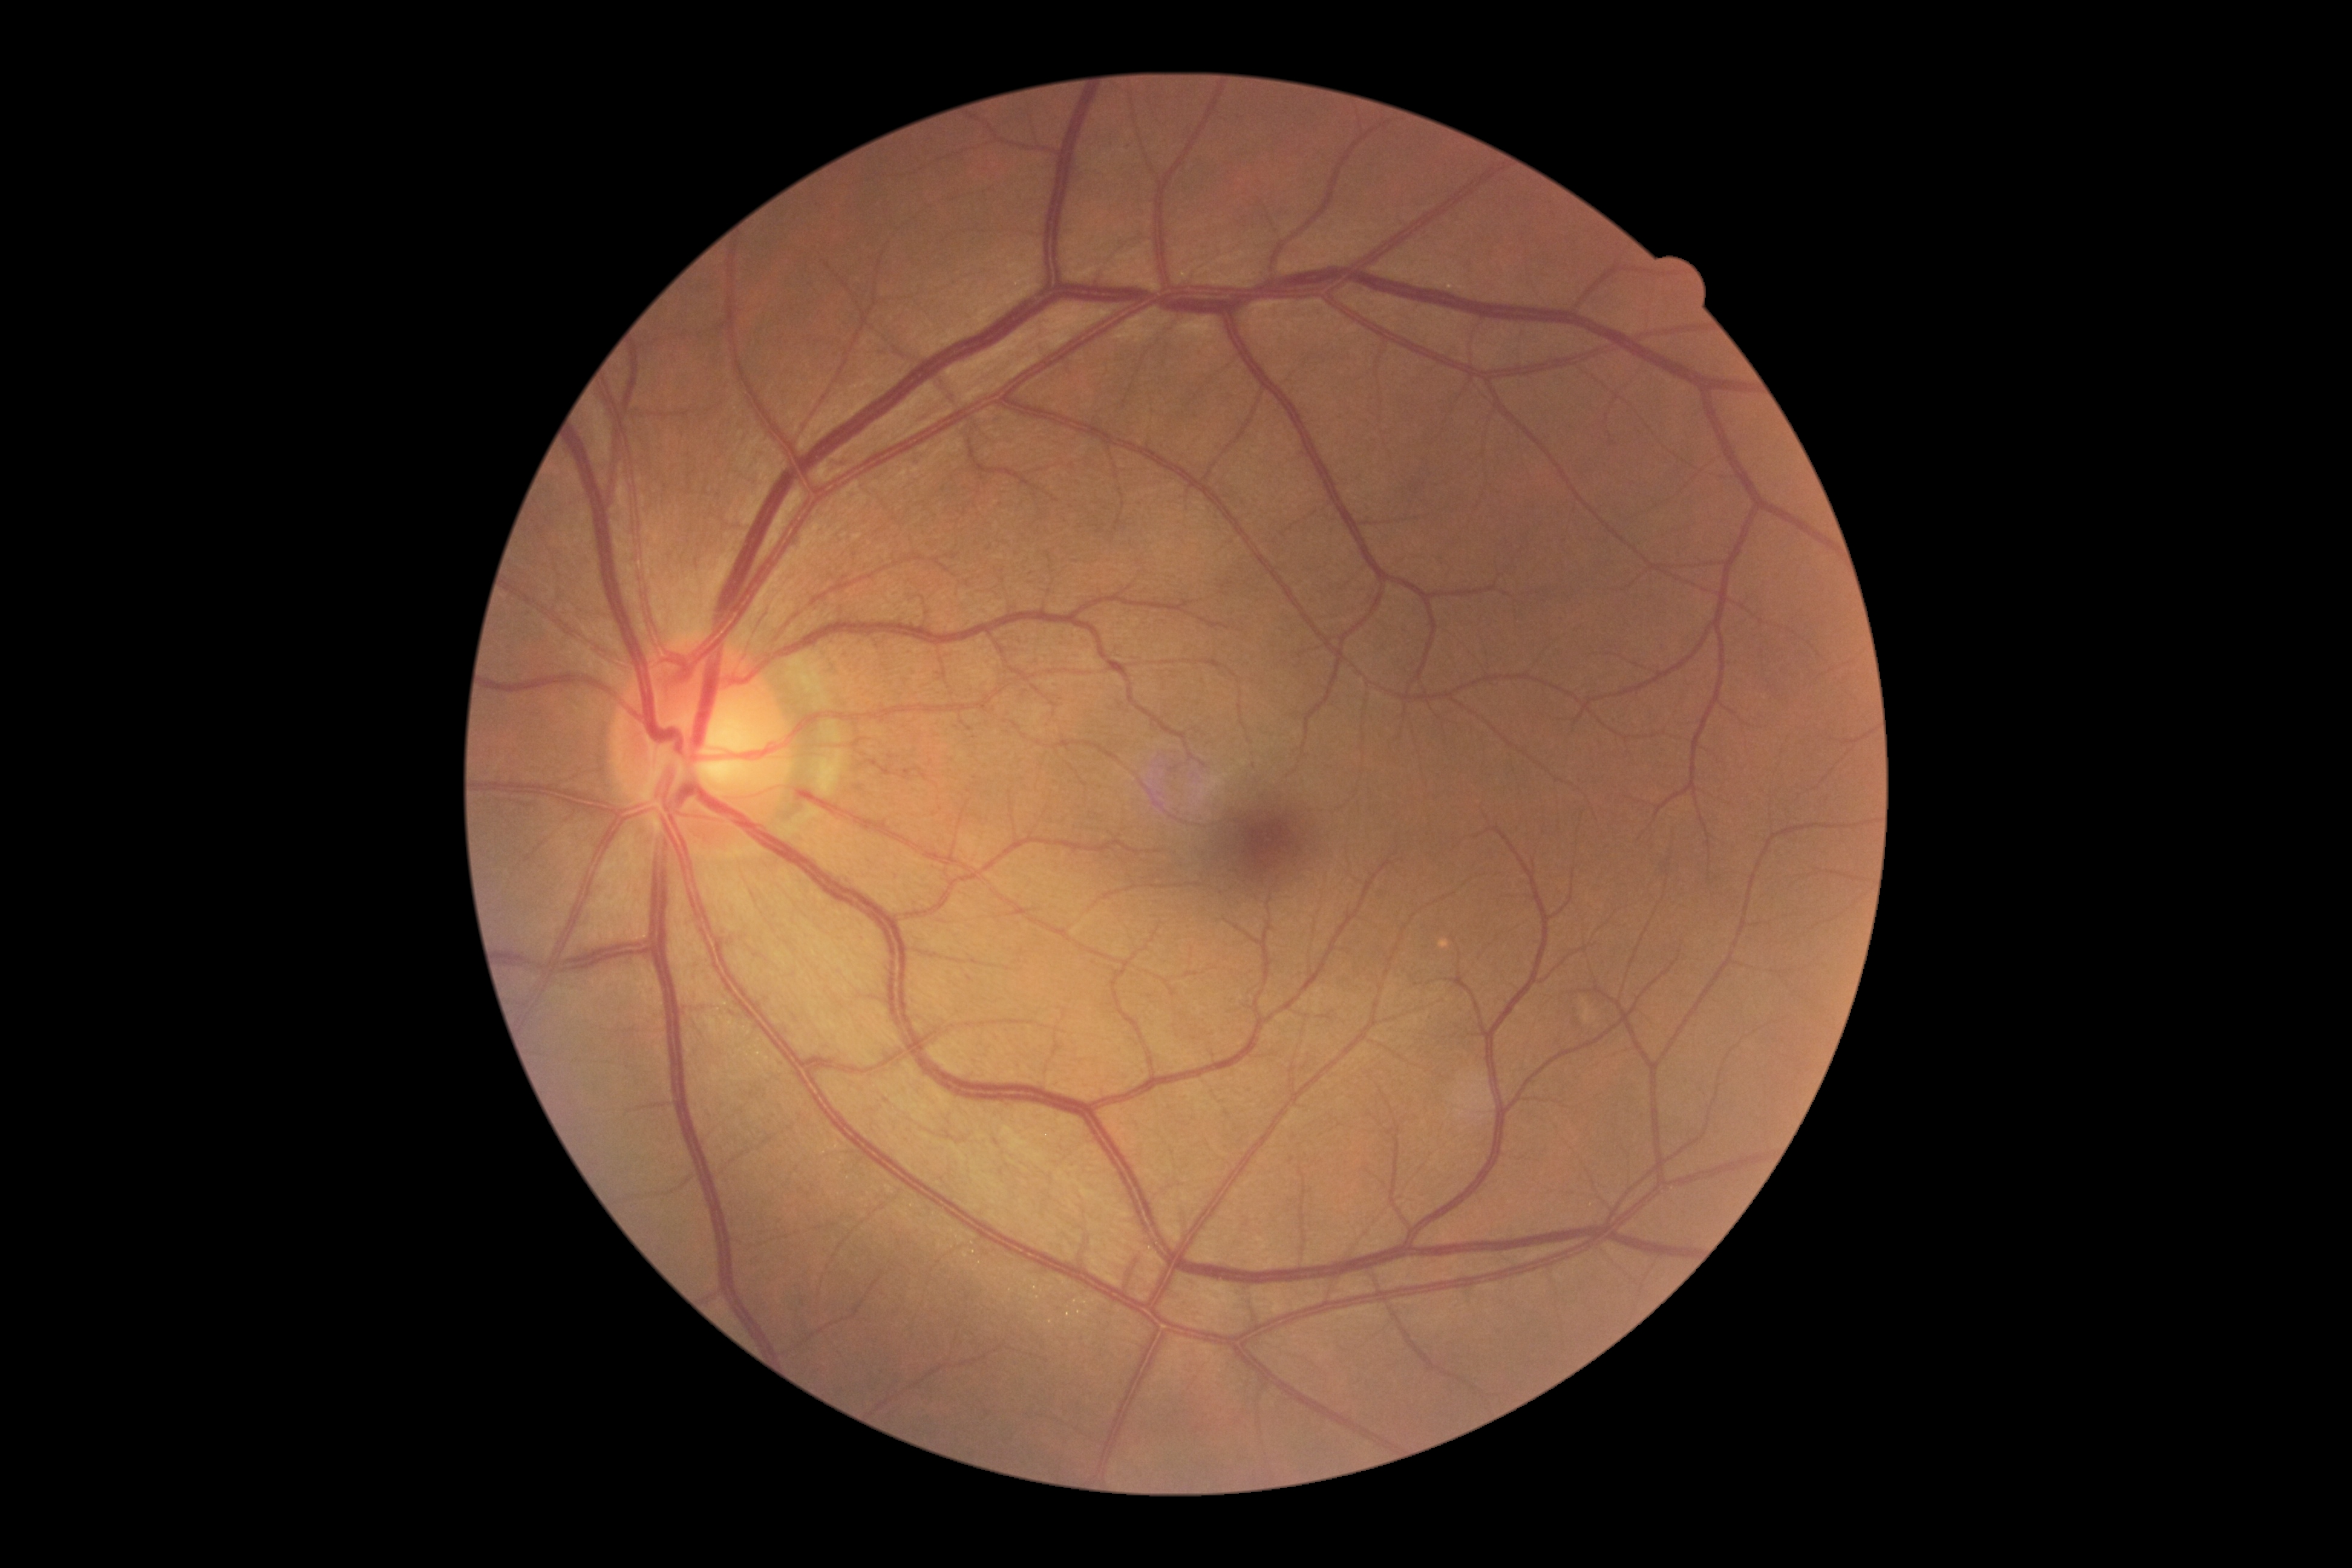 Annotations:
* diabetic retinopathy — grade 0 (no apparent retinopathy)